CFP · 45-degree field of view · NIDEK AFC-230 fundus camera — 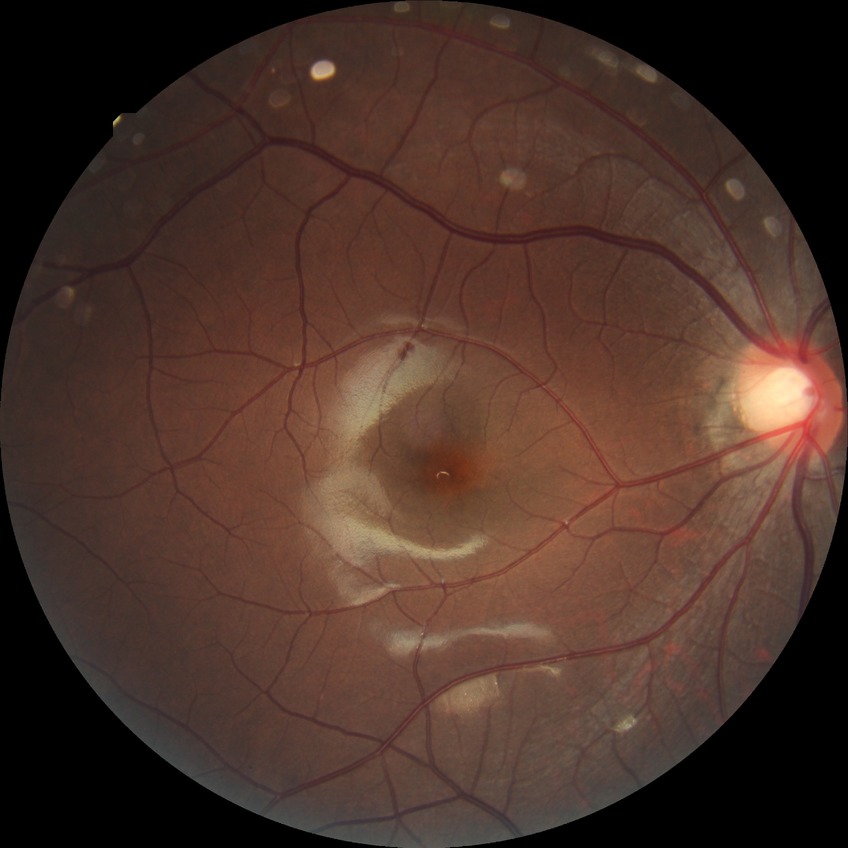 Diabetic retinopathy (DR): NDR (no diabetic retinopathy).